Without pupil dilation; NIDEK AFC-230; 45 degree fundus photograph; posterior pole color fundus photograph — 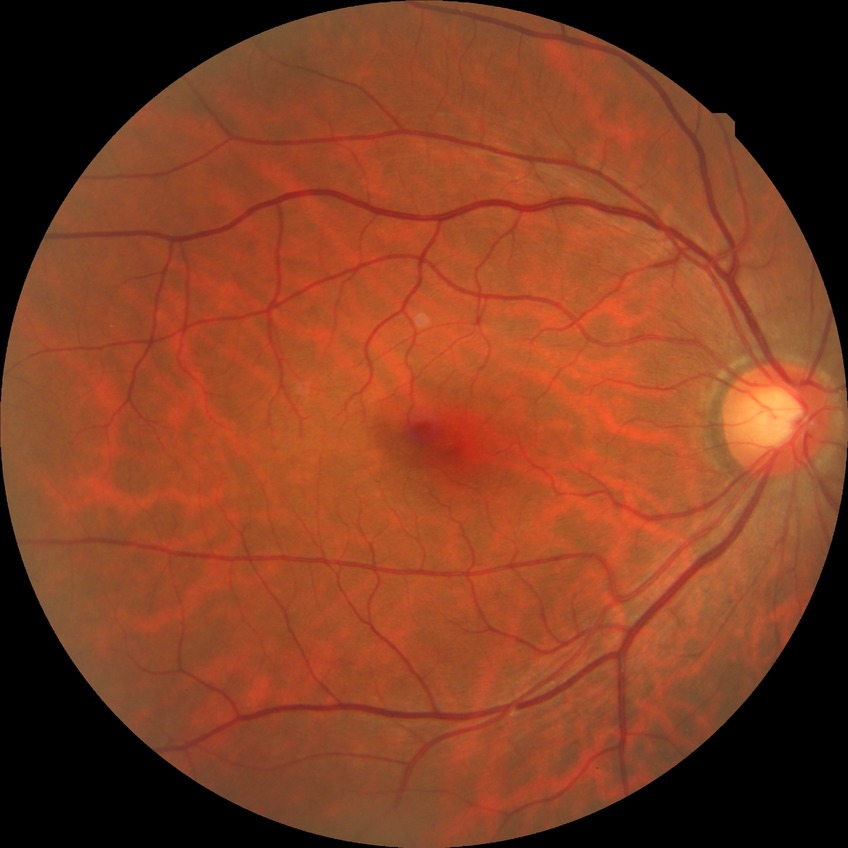

Diabetic retinopathy stage: no diabetic retinopathy.